1659 by 2212 pixels; color fundus photograph — 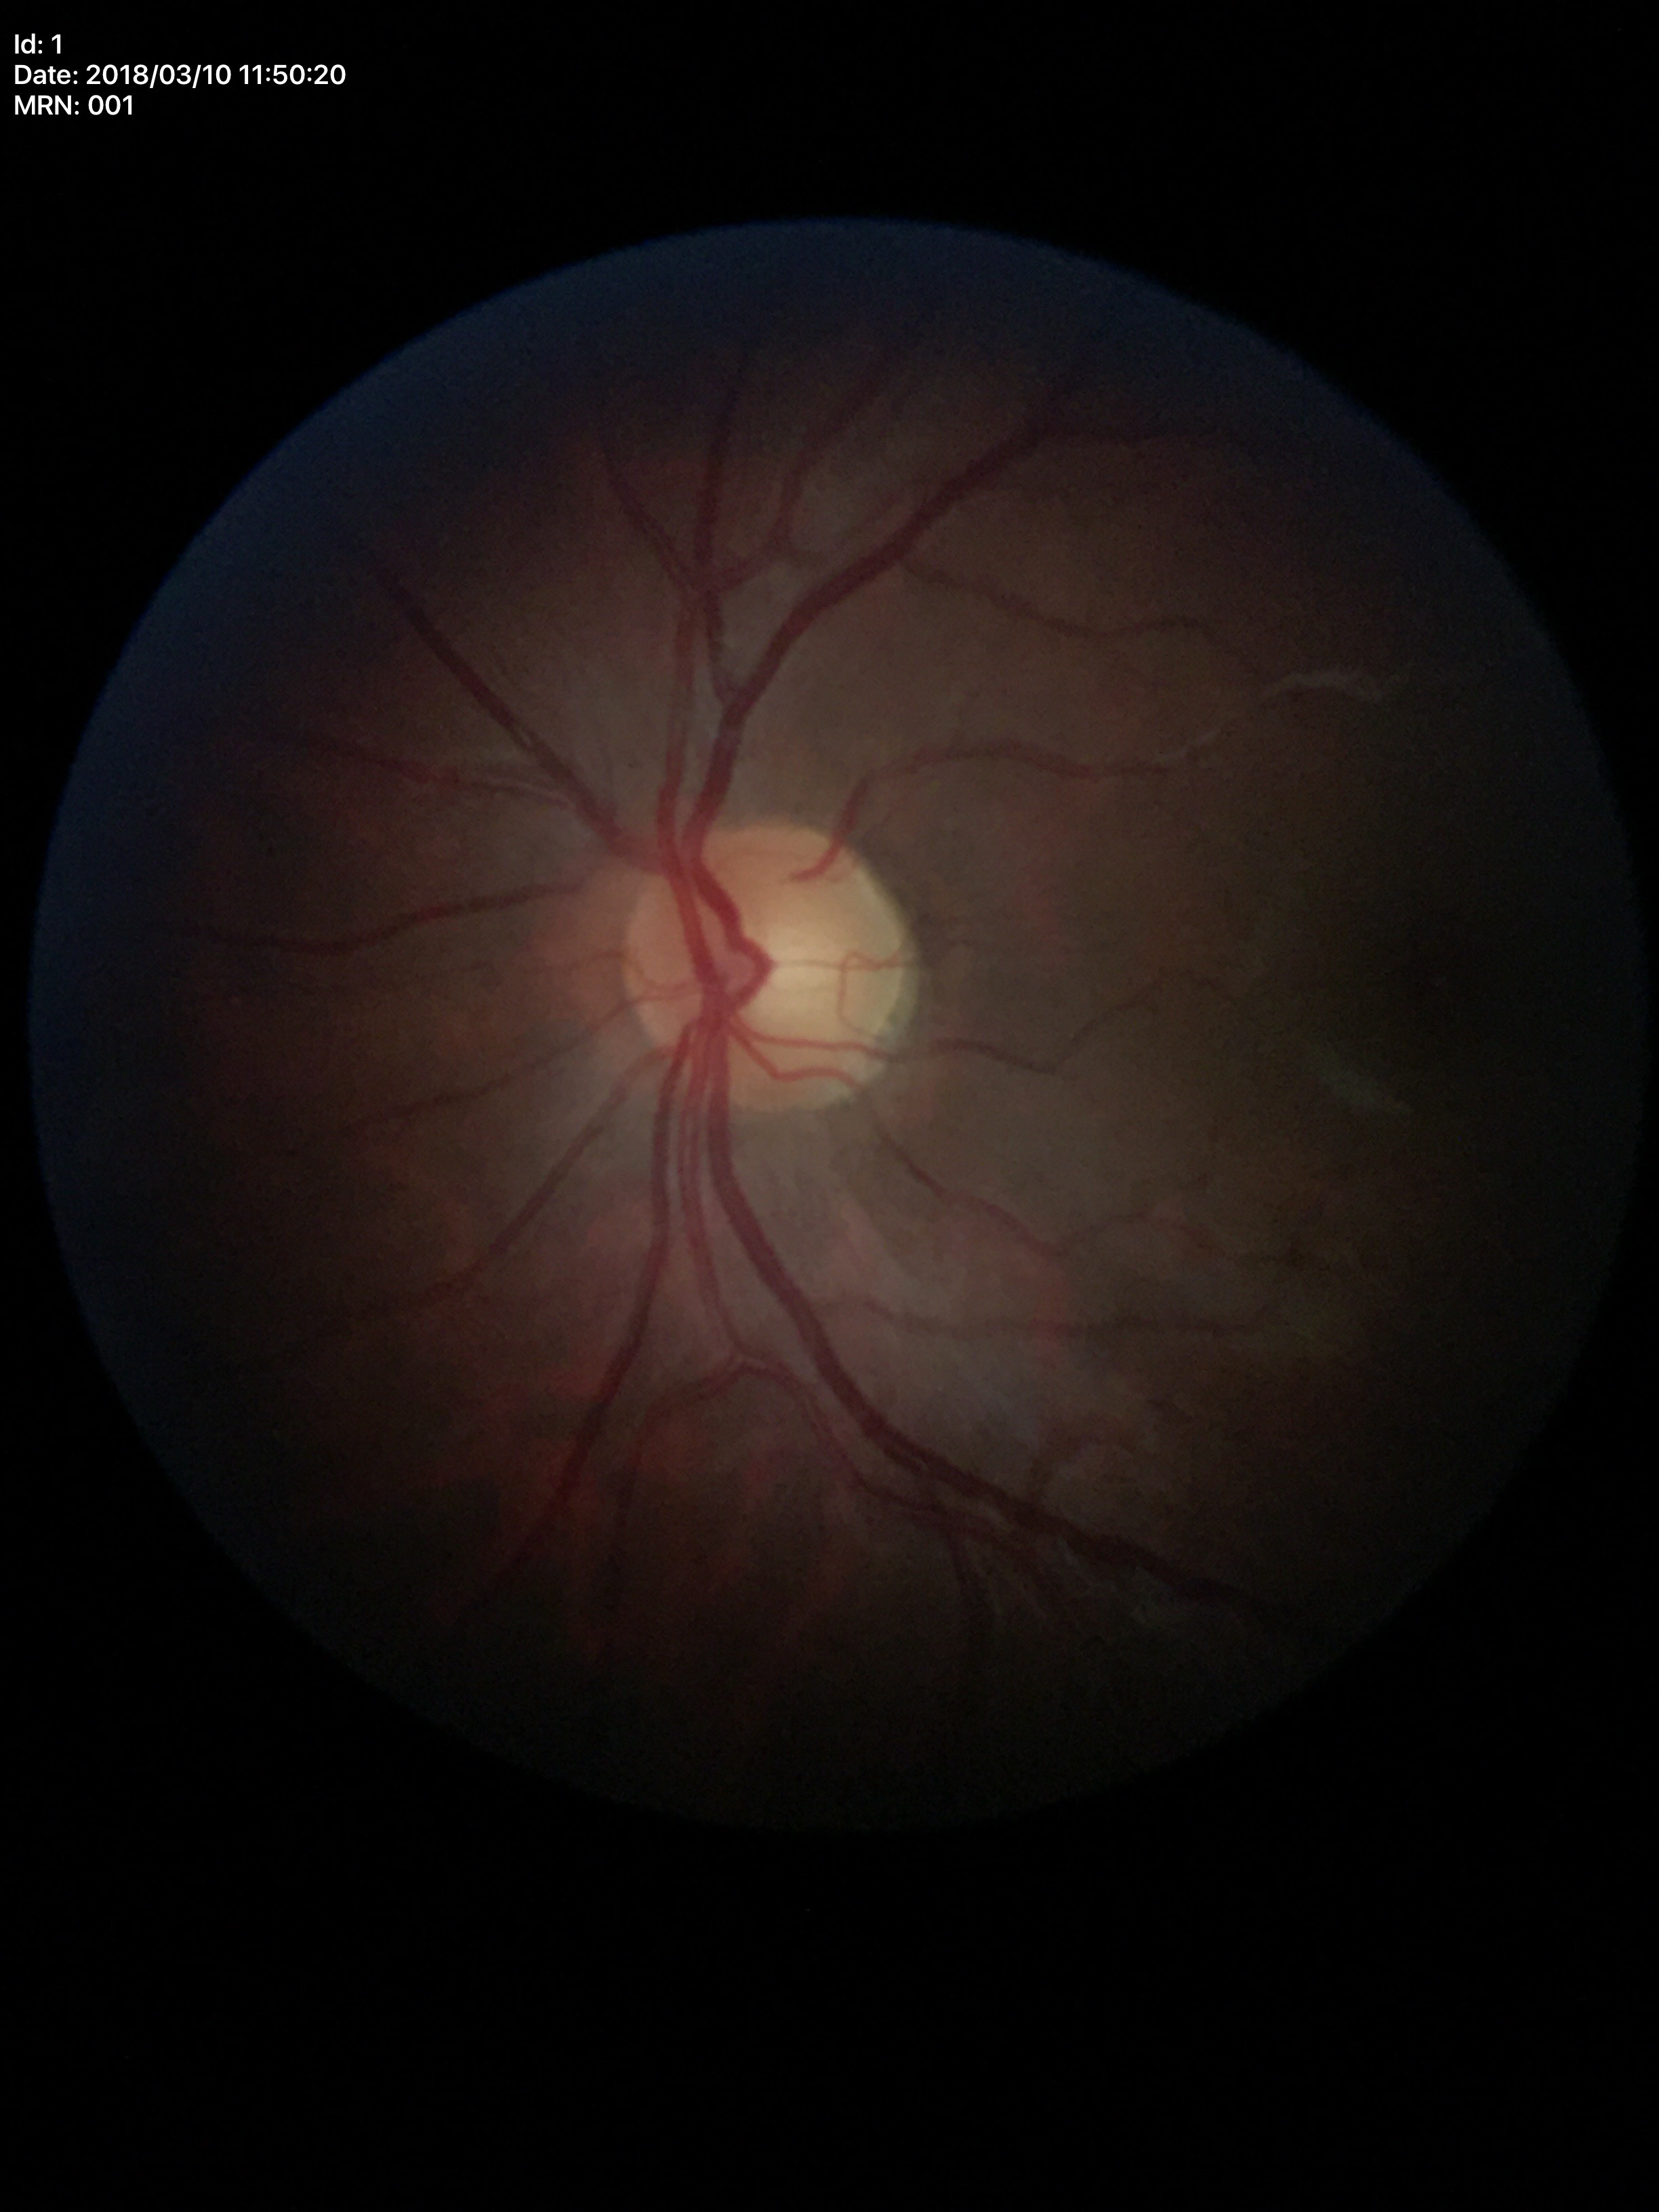 Glaucoma screening impression: no suspicious findings; VCDR: 0.53.